Color fundus photograph:
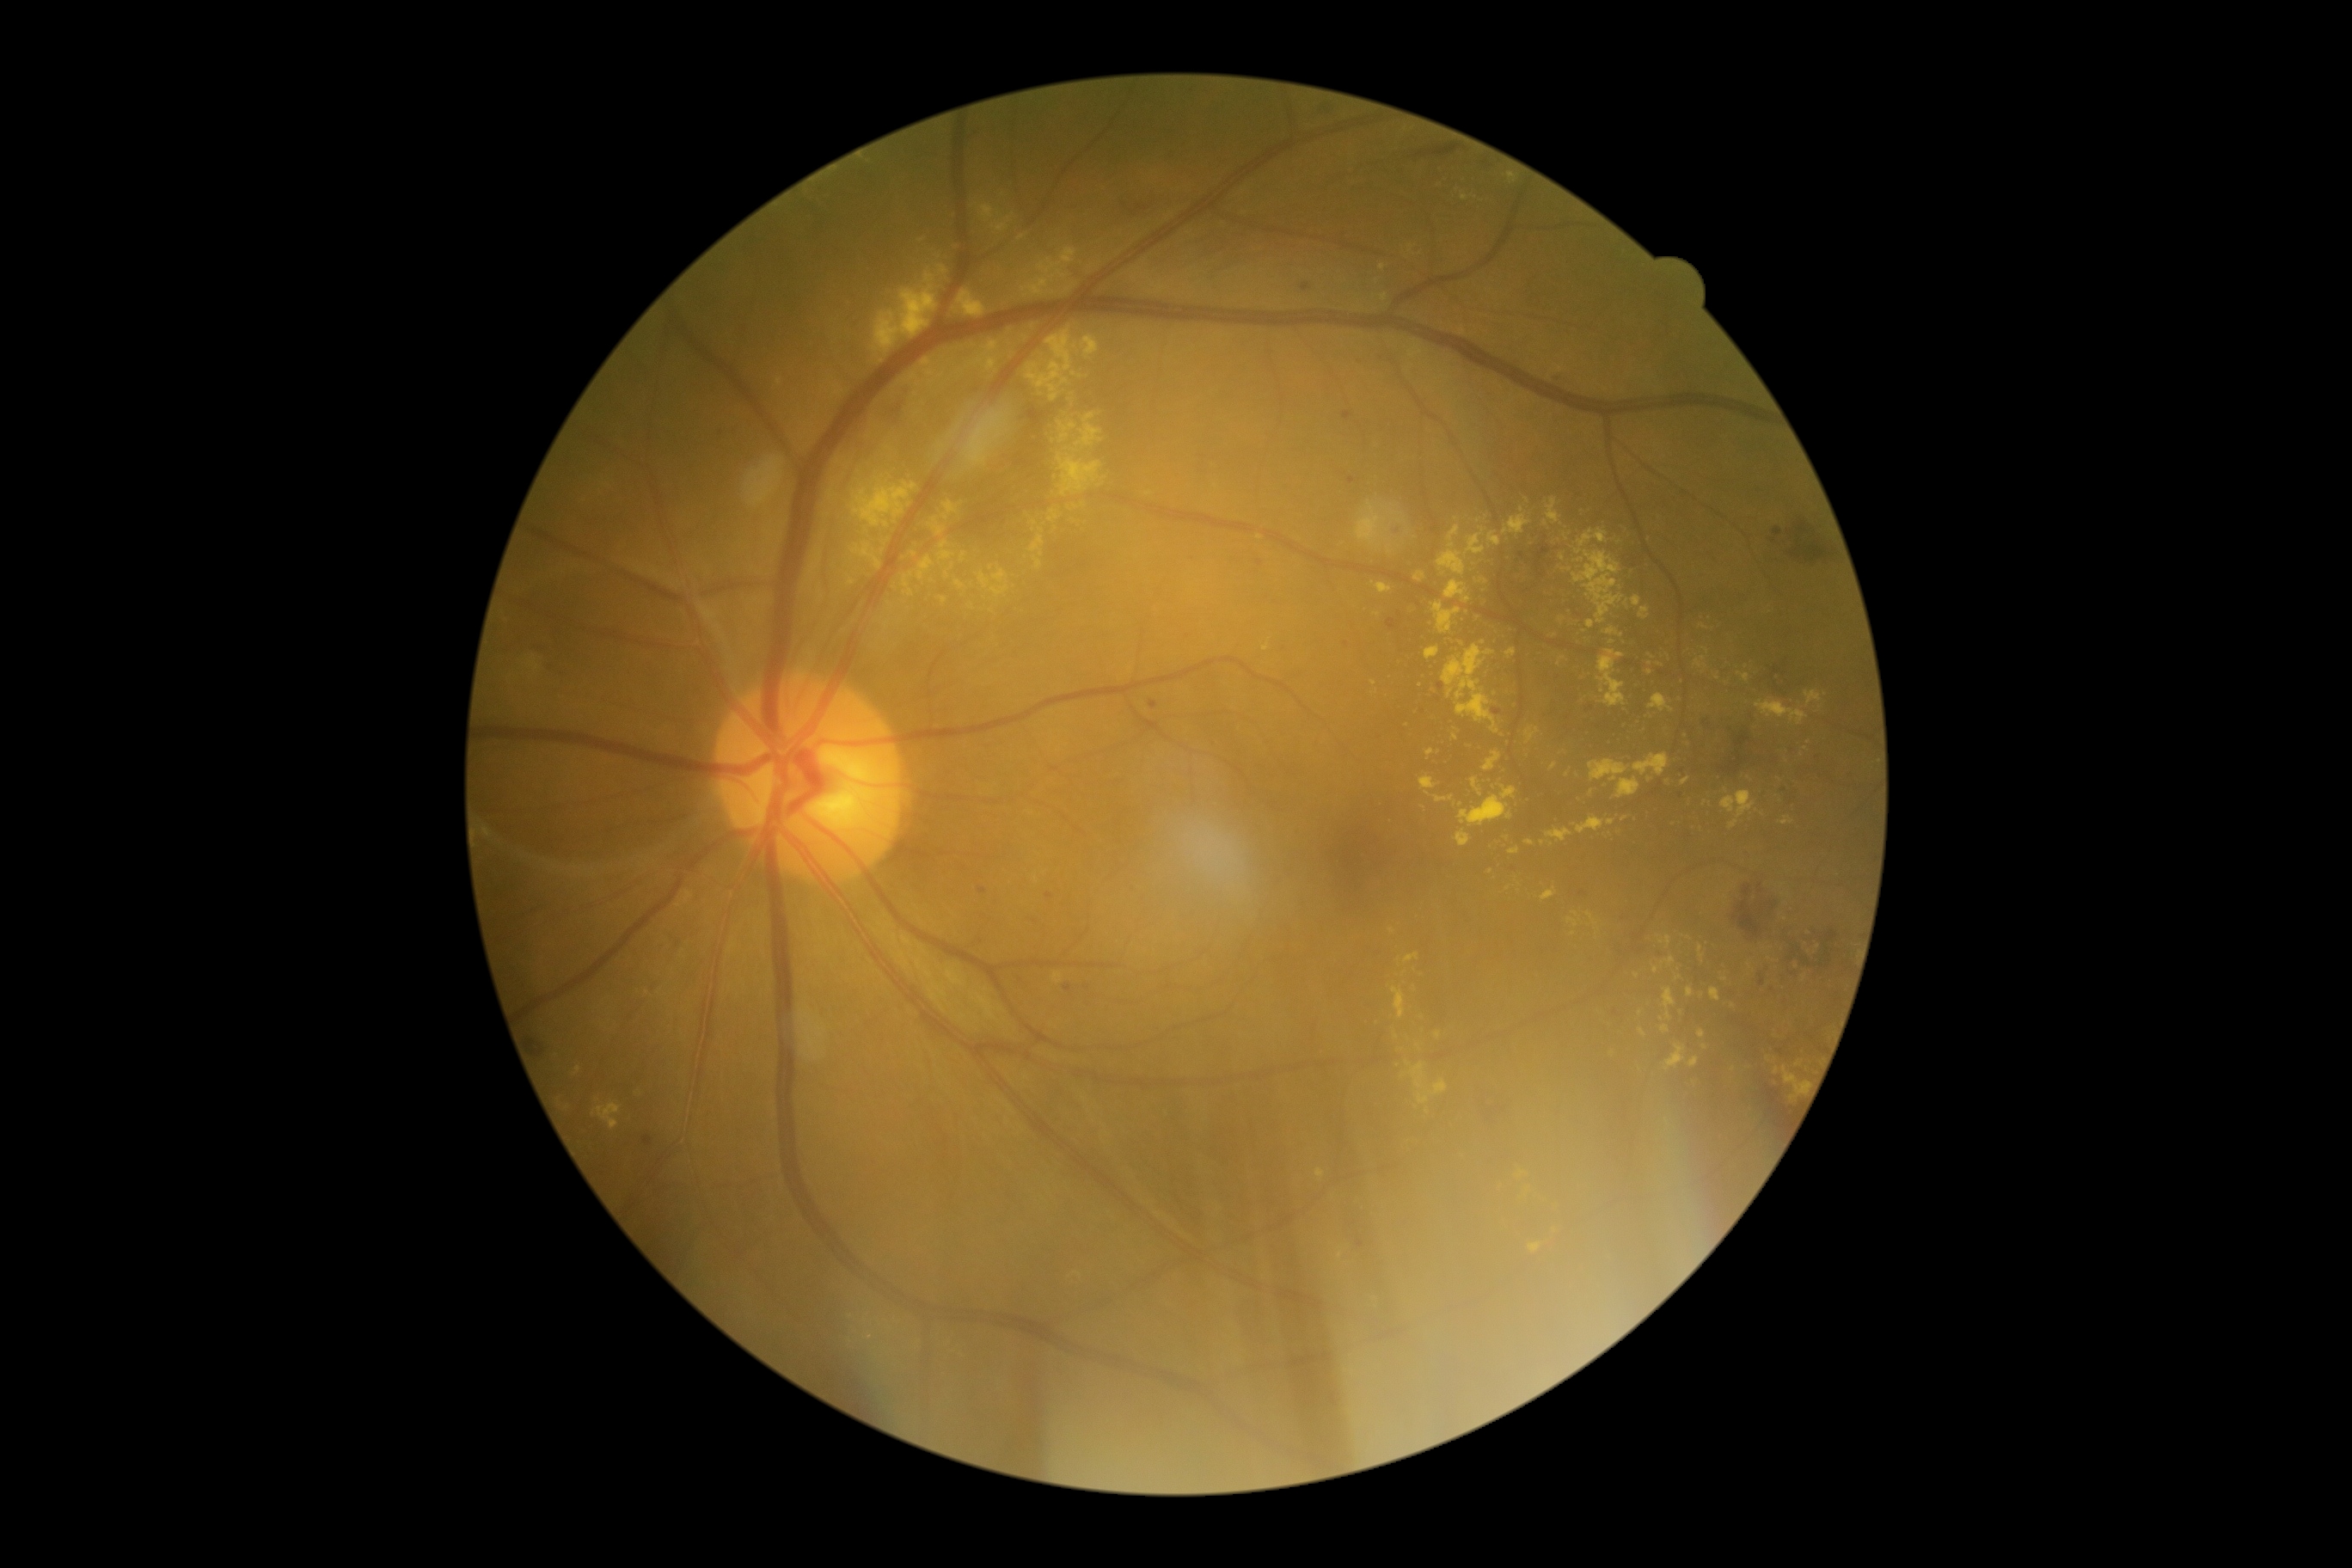

Diabetic retinopathy severity: grade 2 (moderate NPDR)
Representative lesions:
hard exudates (more not shown) = {"left": 831, "top": 384, "right": 845, "bottom": 400} | {"left": 960, "top": 553, "right": 967, "bottom": 563} | {"left": 1464, "top": 527, "right": 1486, "bottom": 558} | {"left": 1632, "top": 596, "right": 1641, "bottom": 608} | {"left": 1653, "top": 965, "right": 1660, "bottom": 974} | {"left": 1371, "top": 582, "right": 1393, "bottom": 594} | {"left": 1058, "top": 422, "right": 1077, "bottom": 444} | {"left": 1722, "top": 790, "right": 1756, "bottom": 819} | {"left": 1507, "top": 647, "right": 1517, "bottom": 659} | {"left": 1032, "top": 556, "right": 1043, "bottom": 572} | {"left": 848, "top": 474, "right": 917, "bottom": 536}
Hard exudates (small, approximate centers) near x=1611 y=822 | x=1562 y=557 | x=1624 y=819 | x=991 y=568 | x=1705 y=1047 | x=1734 y=1068 | x=1054 y=293 | x=1462 y=644 | x=1021 y=239